45° FOV. Retinal fundus photograph.
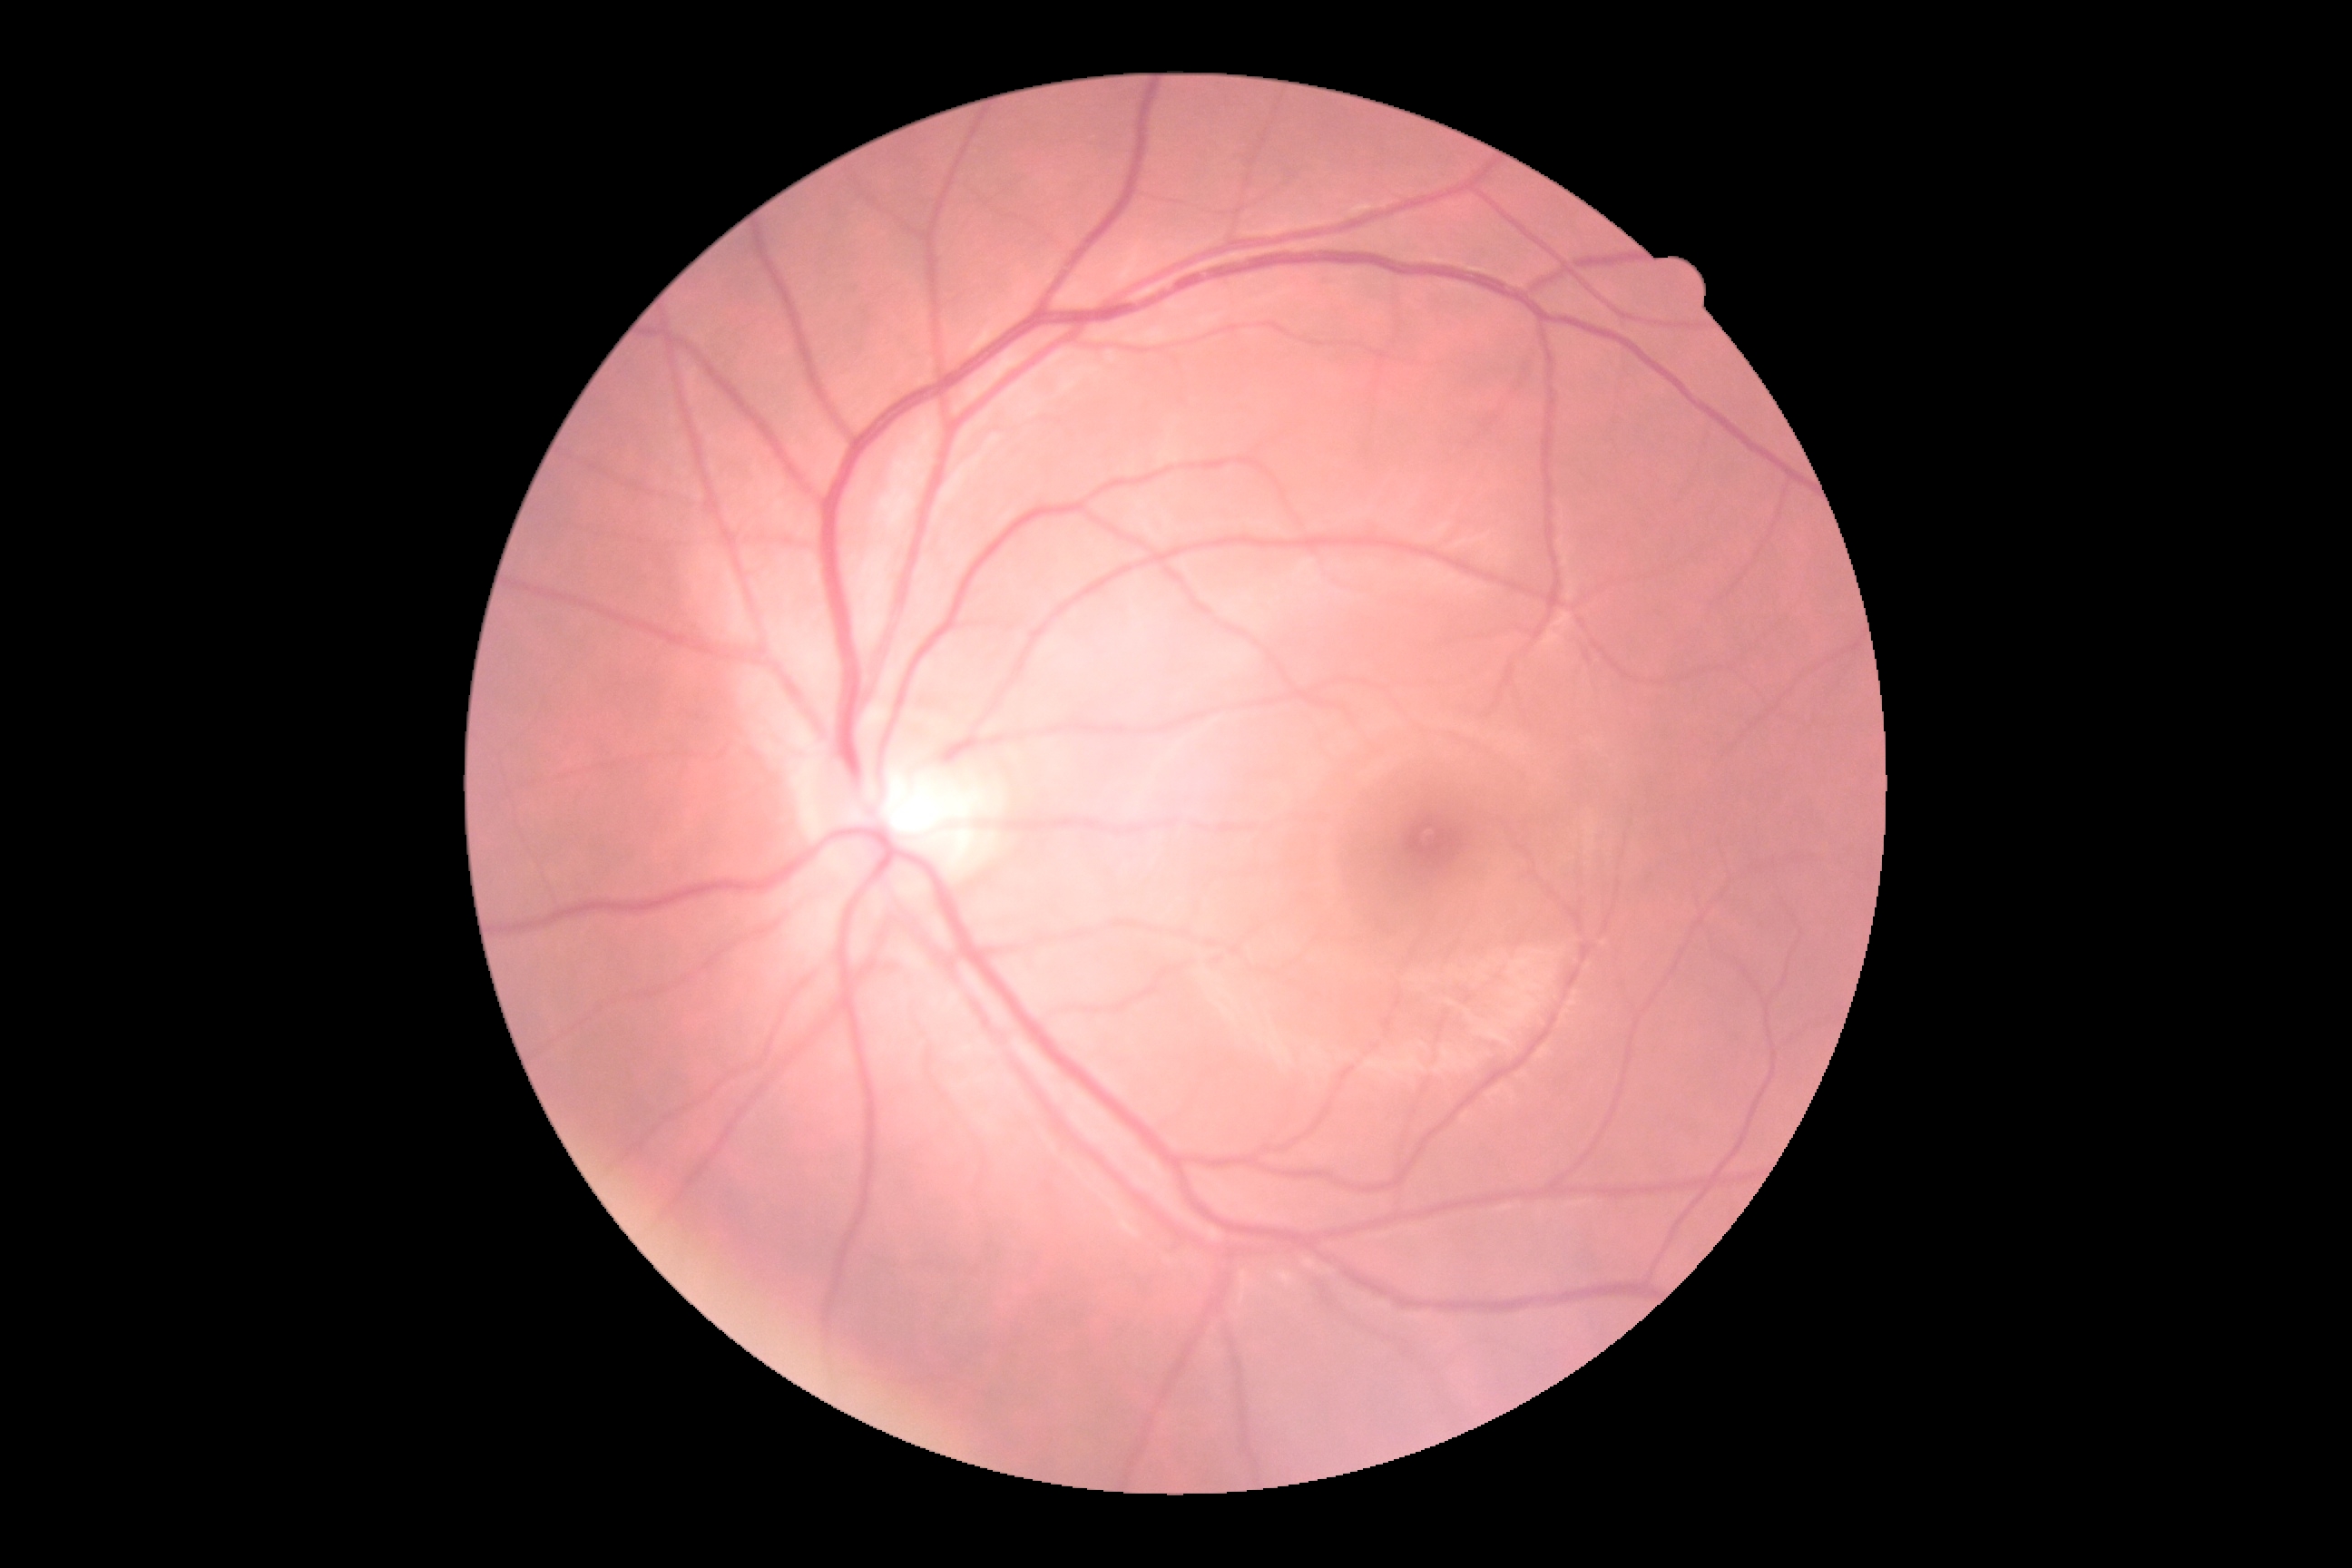

DR impression@no signs of DR, diabetic retinopathy severity@no apparent retinopathy (grade 0).